Acquired on the Phoenix ICON. 1240x1240. Wide-field fundus image from infant ROP screening:
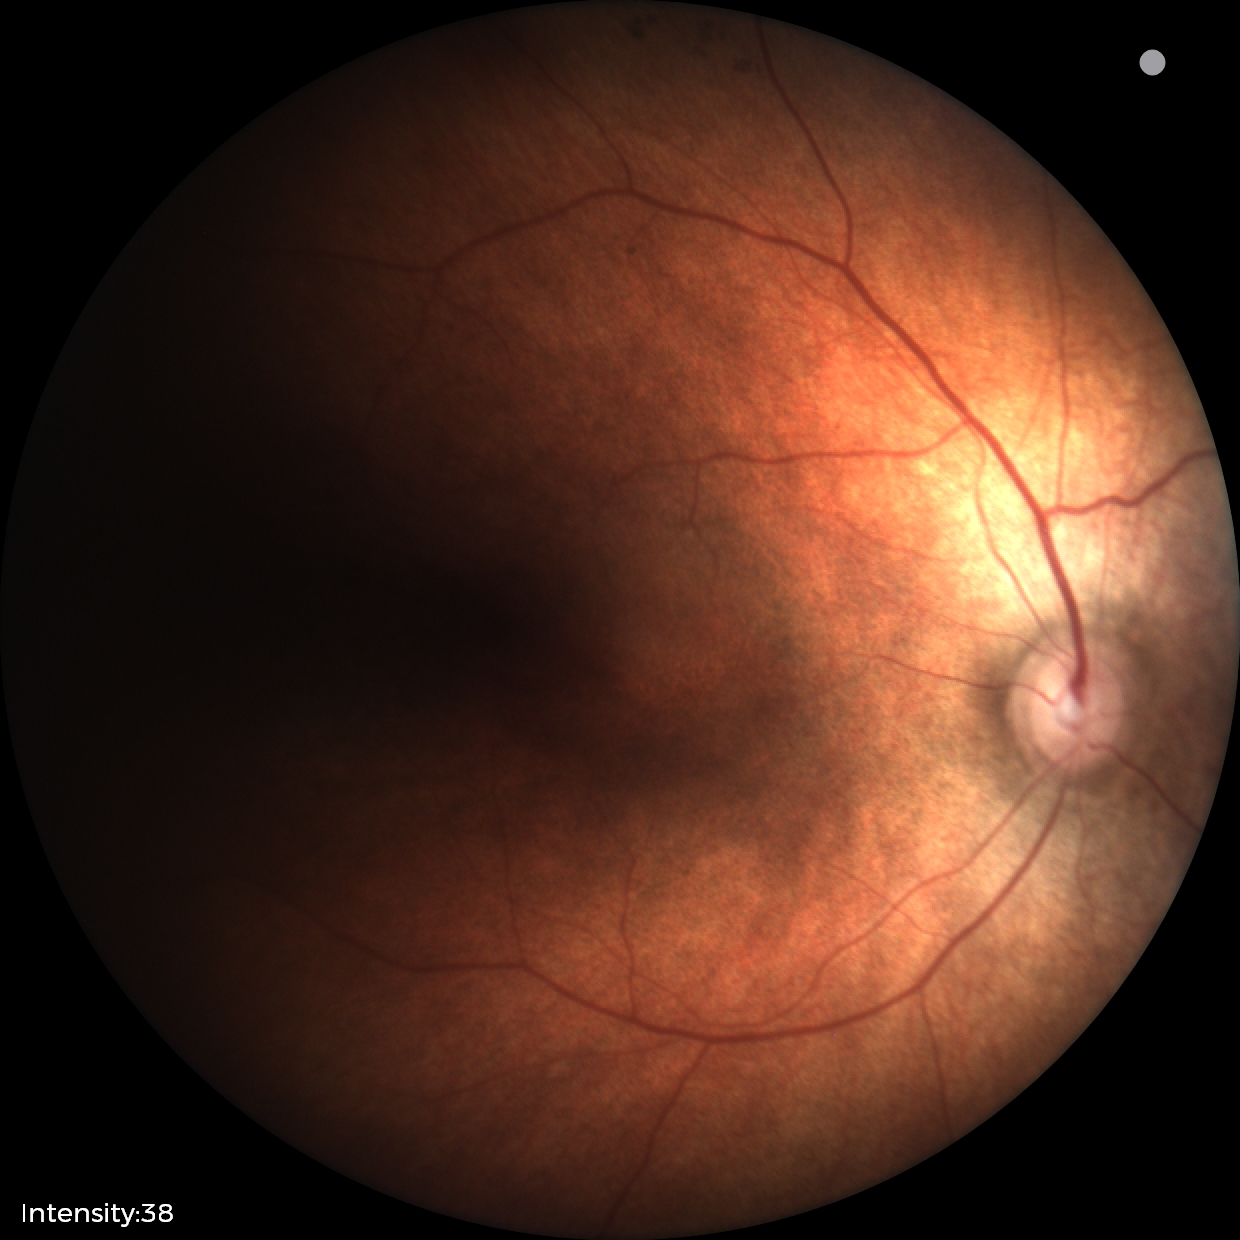

Normal screening examination.